Camera: Nidek AFC-330: 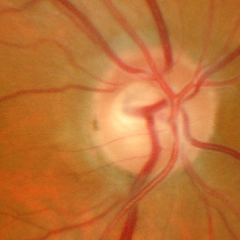

Glaucoma diagnosis: advanced-stage glaucoma.